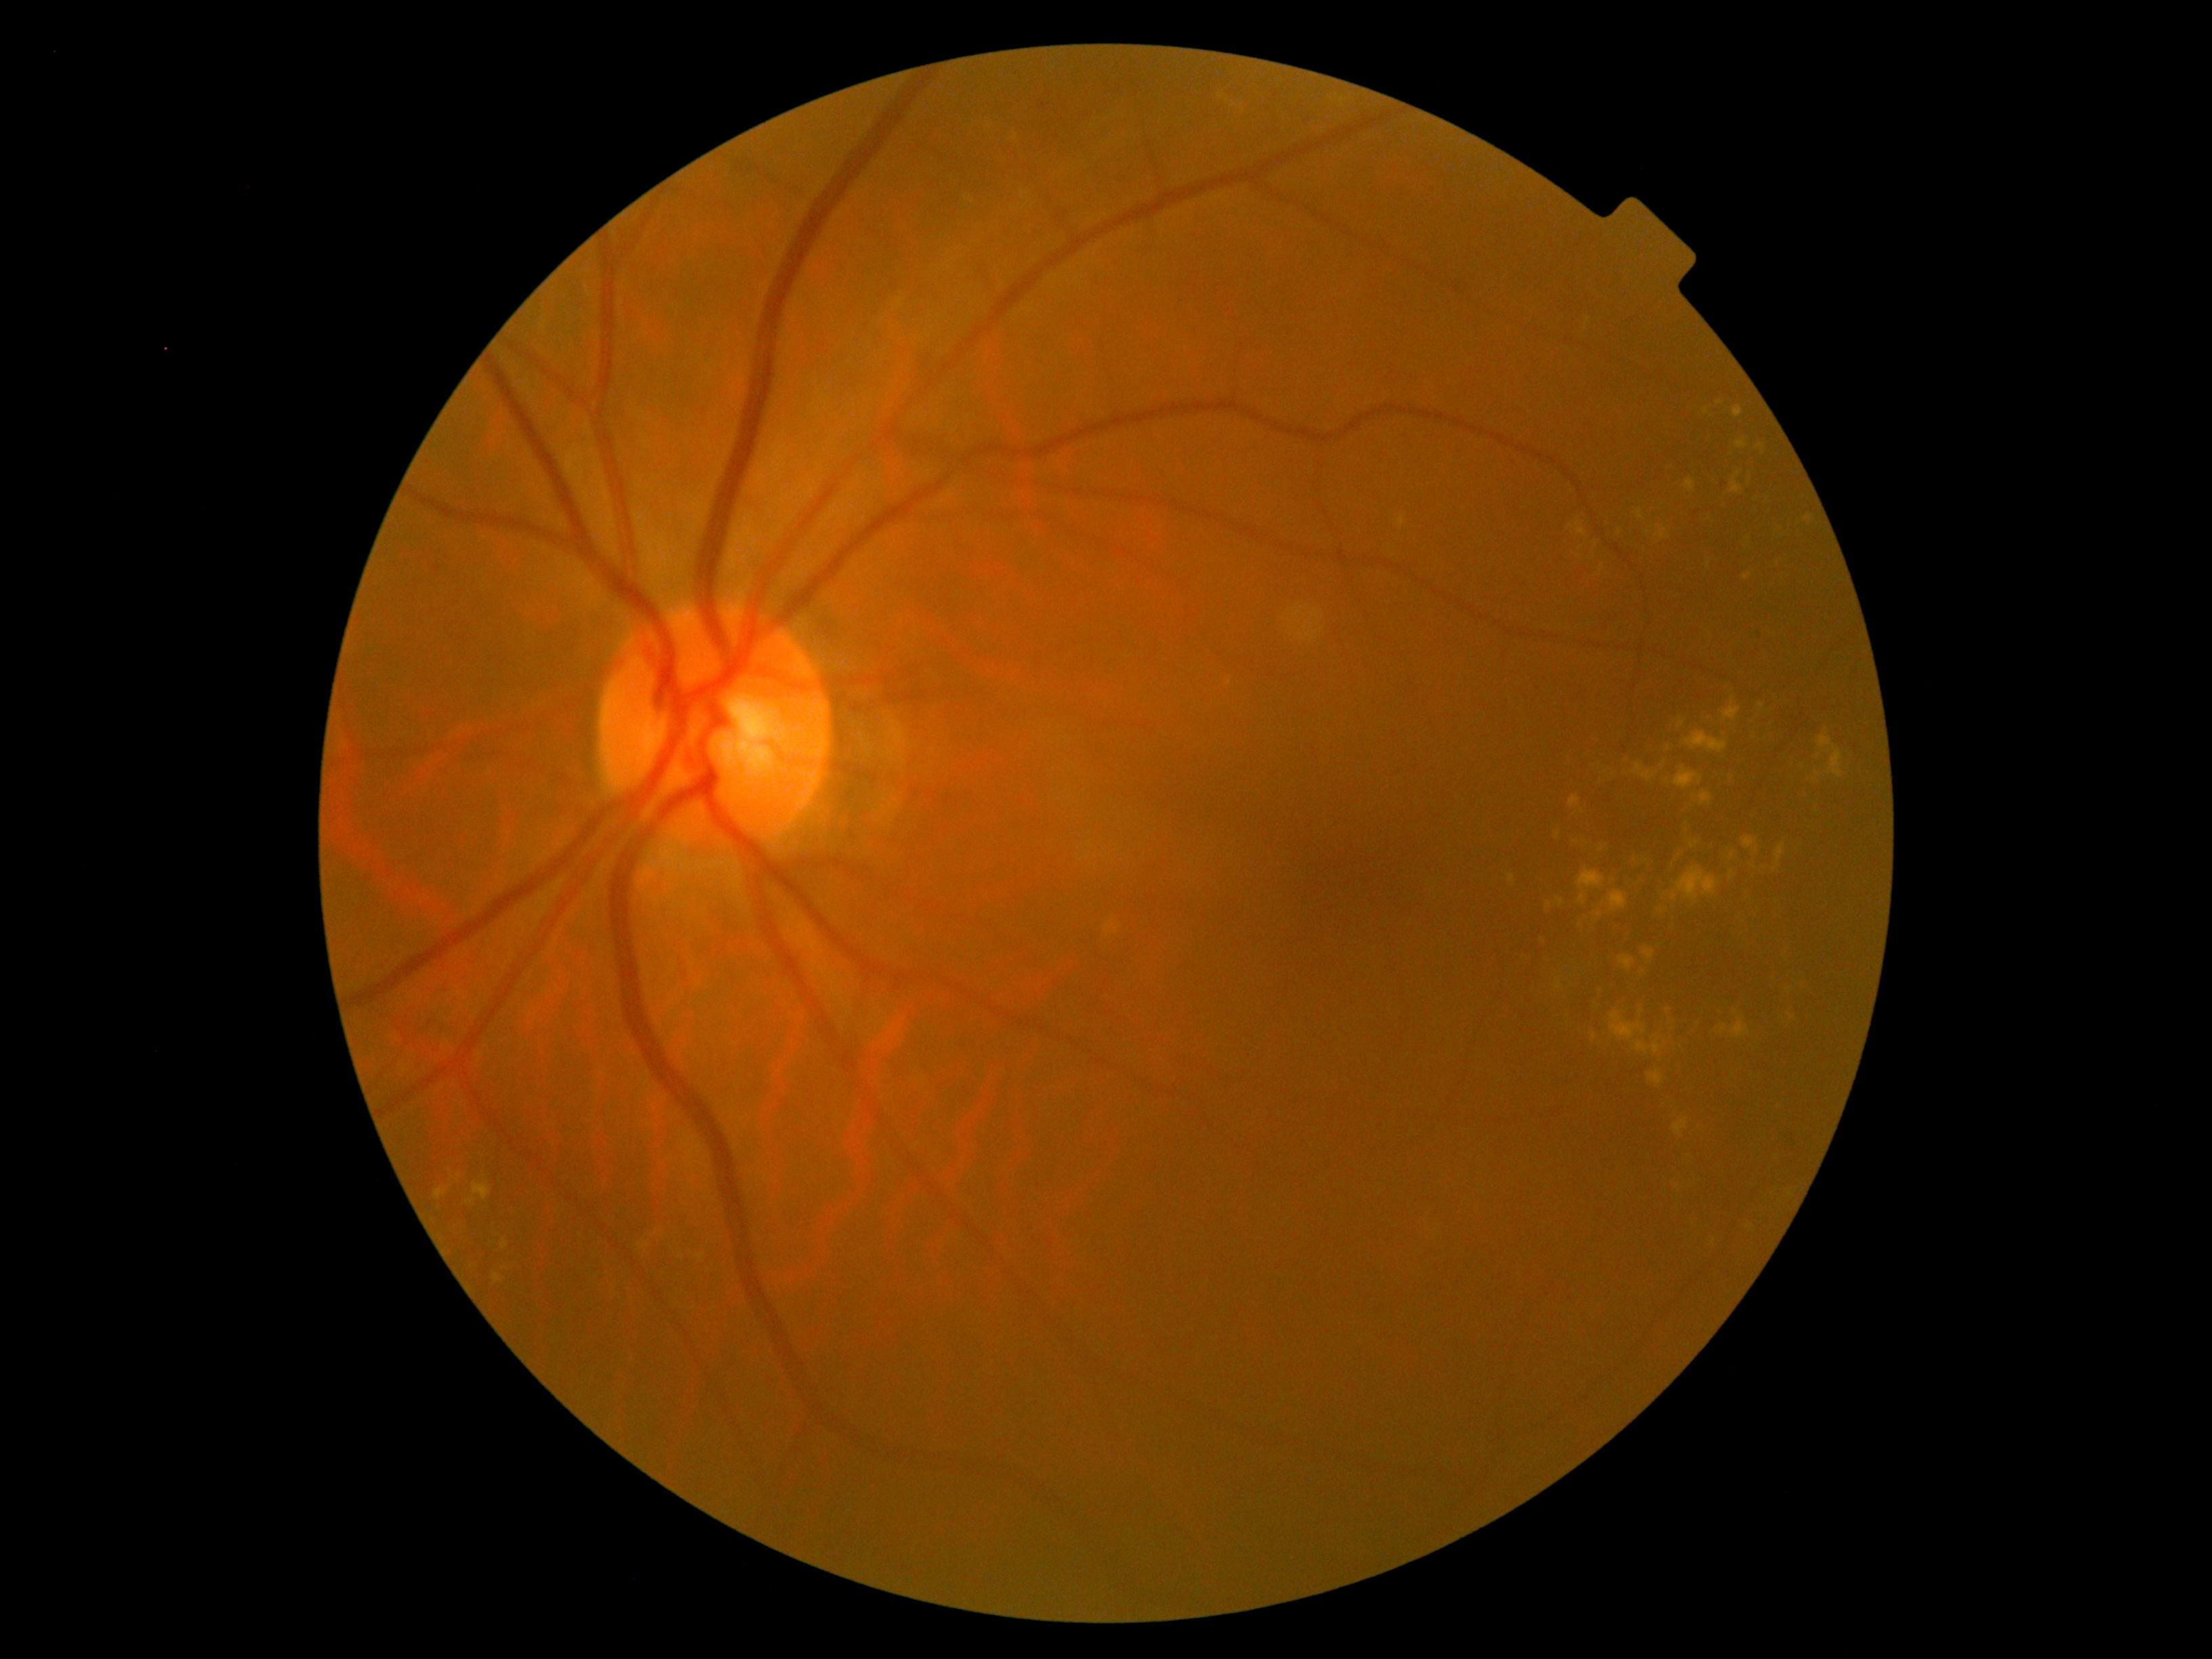
DR class=non-proliferative diabetic retinopathy, diabetic retinopathy grade=moderate non-proliferative diabetic retinopathy (2).